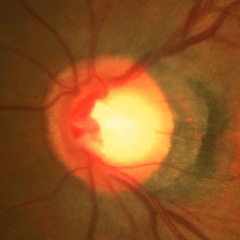 Q: Is glaucoma present?
A: No — no signs of glaucoma.